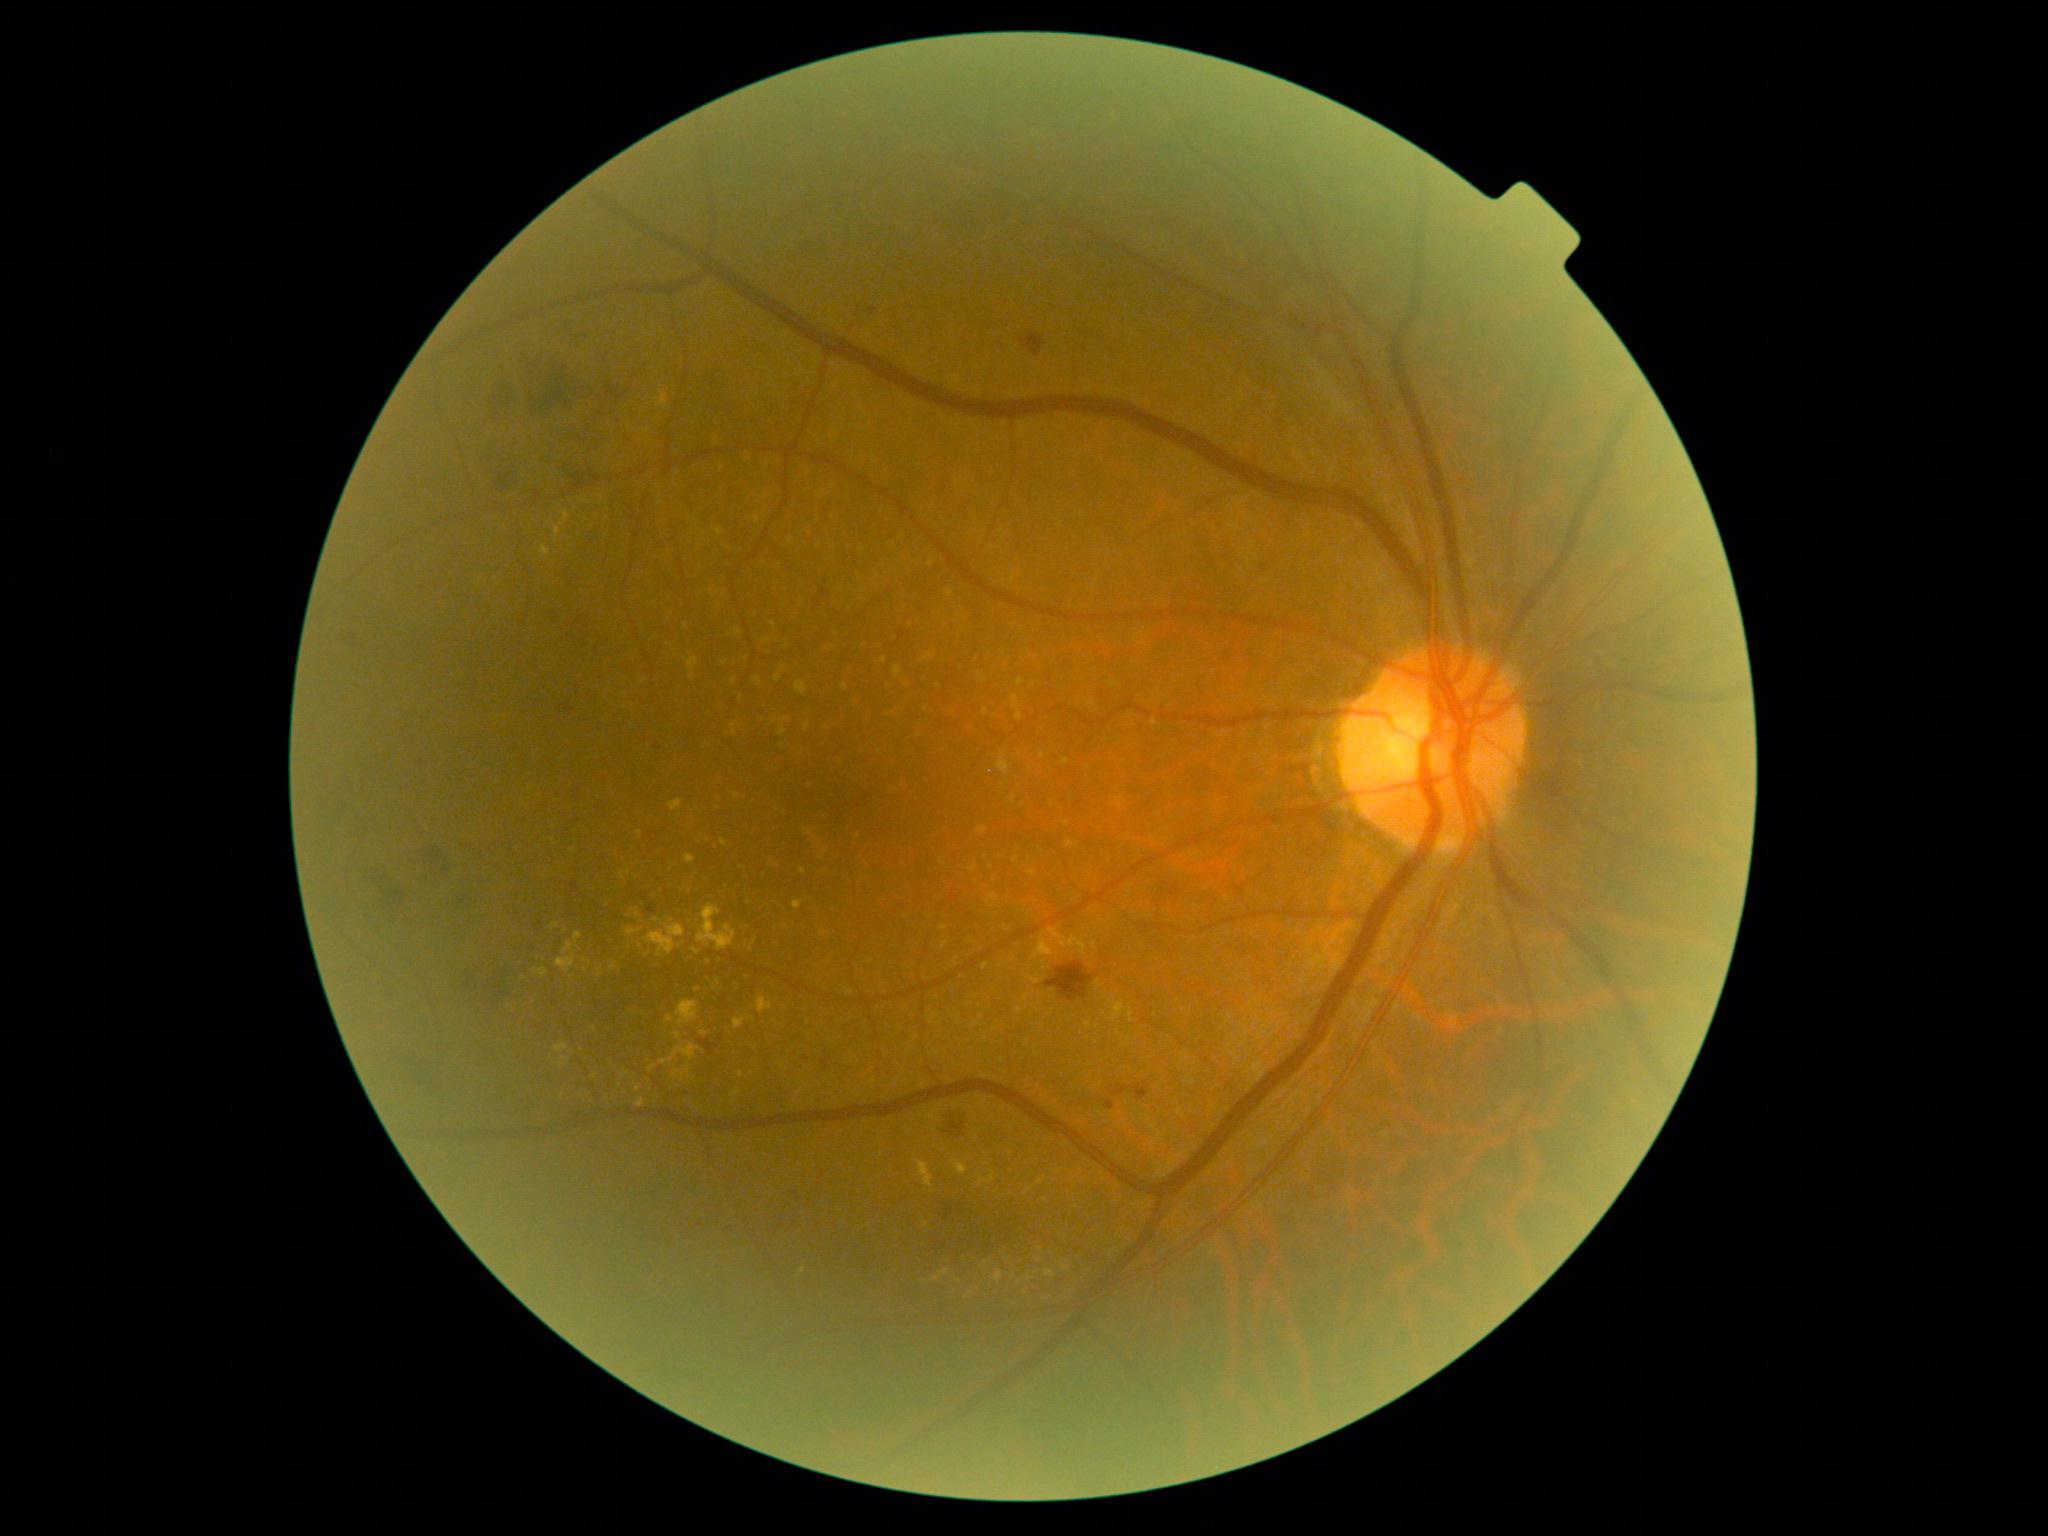

Diabetic retinopathy grade is 2 (moderate NPDR); non-proliferative diabetic retinopathy.
Hemorrhages include lesions at [552, 454, 598, 489]; [790, 1188, 823, 1198]; [940, 1194, 976, 1223]; [480, 437, 525, 490]; [451, 875, 486, 915]; [1105, 1099, 1115, 1111]; [411, 838, 451, 877]; [822, 1059, 829, 1070]; [492, 373, 517, 419]; [342, 630, 365, 654]; [530, 350, 602, 411]; [1046, 961, 1095, 1002]; [869, 307, 878, 314]; [938, 466, 958, 498]; [598, 350, 650, 404]; [815, 600, 822, 608]; [821, 588, 831, 598].
No soft exudates identified.
No microaneurysms identified.
Hard exudates include lesions at [558, 1056, 568, 1068]; [552, 923, 560, 928]; [555, 526, 560, 541]; [635, 1085, 642, 1093]; [627, 927, 642, 937]; [793, 901, 803, 910]; [685, 855, 696, 864]; [697, 905, 737, 951]; [655, 391, 668, 407]; [1026, 1276, 1035, 1282]; [677, 1001, 700, 1026].
Small hard exudates near point(626, 1073); point(670, 922); point(1060, 1171); point(708, 840); point(595, 1029); point(649, 955); point(1028, 1191).